Clarity RetCam 3, 130° FOV; wide-field fundus image from infant ROP screening; 640x480
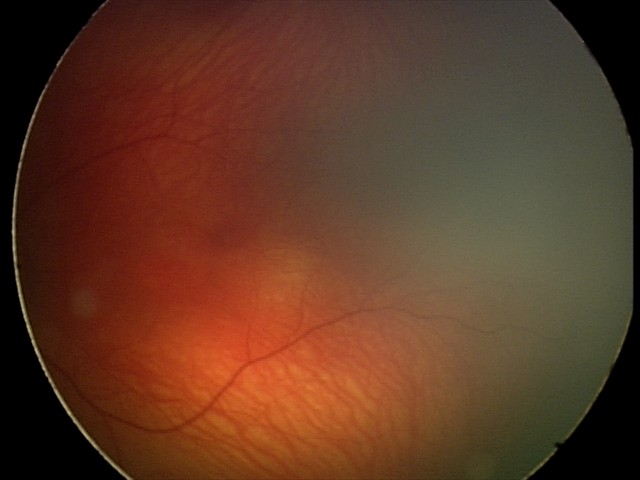
Q: What is the screening diagnosis?
A: physiological finding